240x240; captured without pupil dilation: 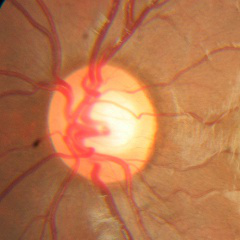

Impression: no glaucoma.